45-degree field of view, fundus photo, image size 2184x1690.
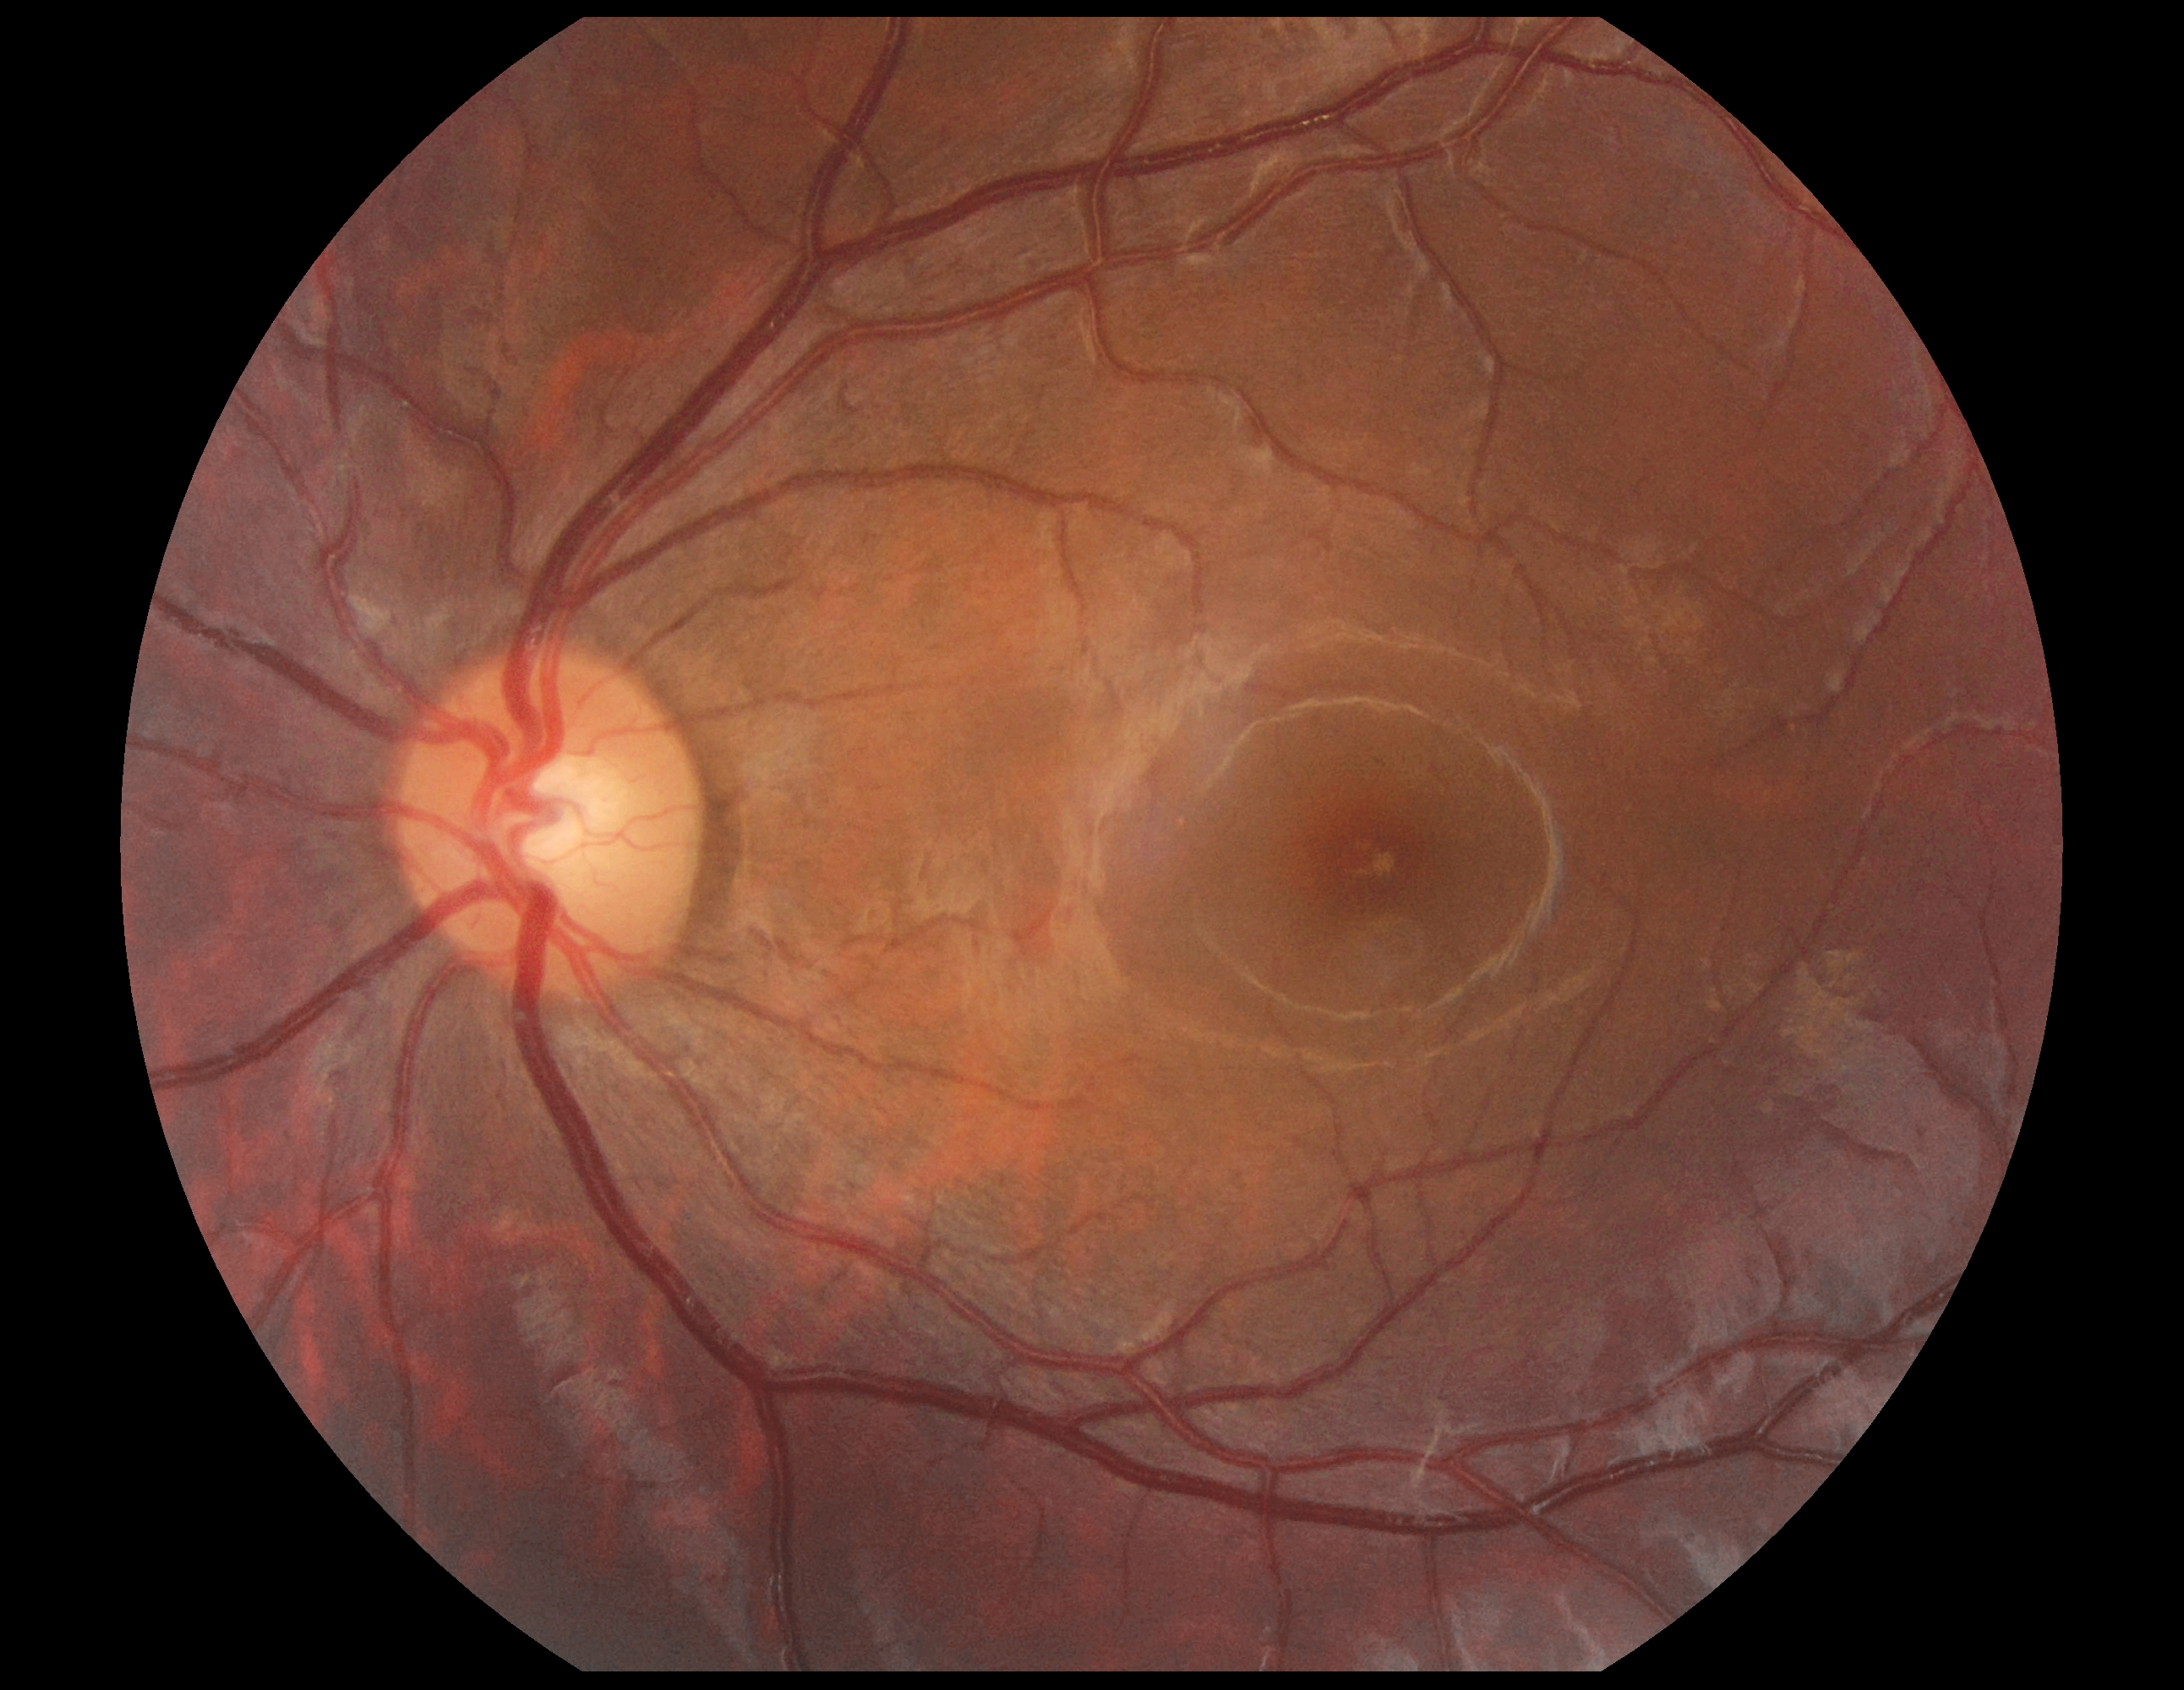

Retinopathy: 0/4.